2212x1672px: 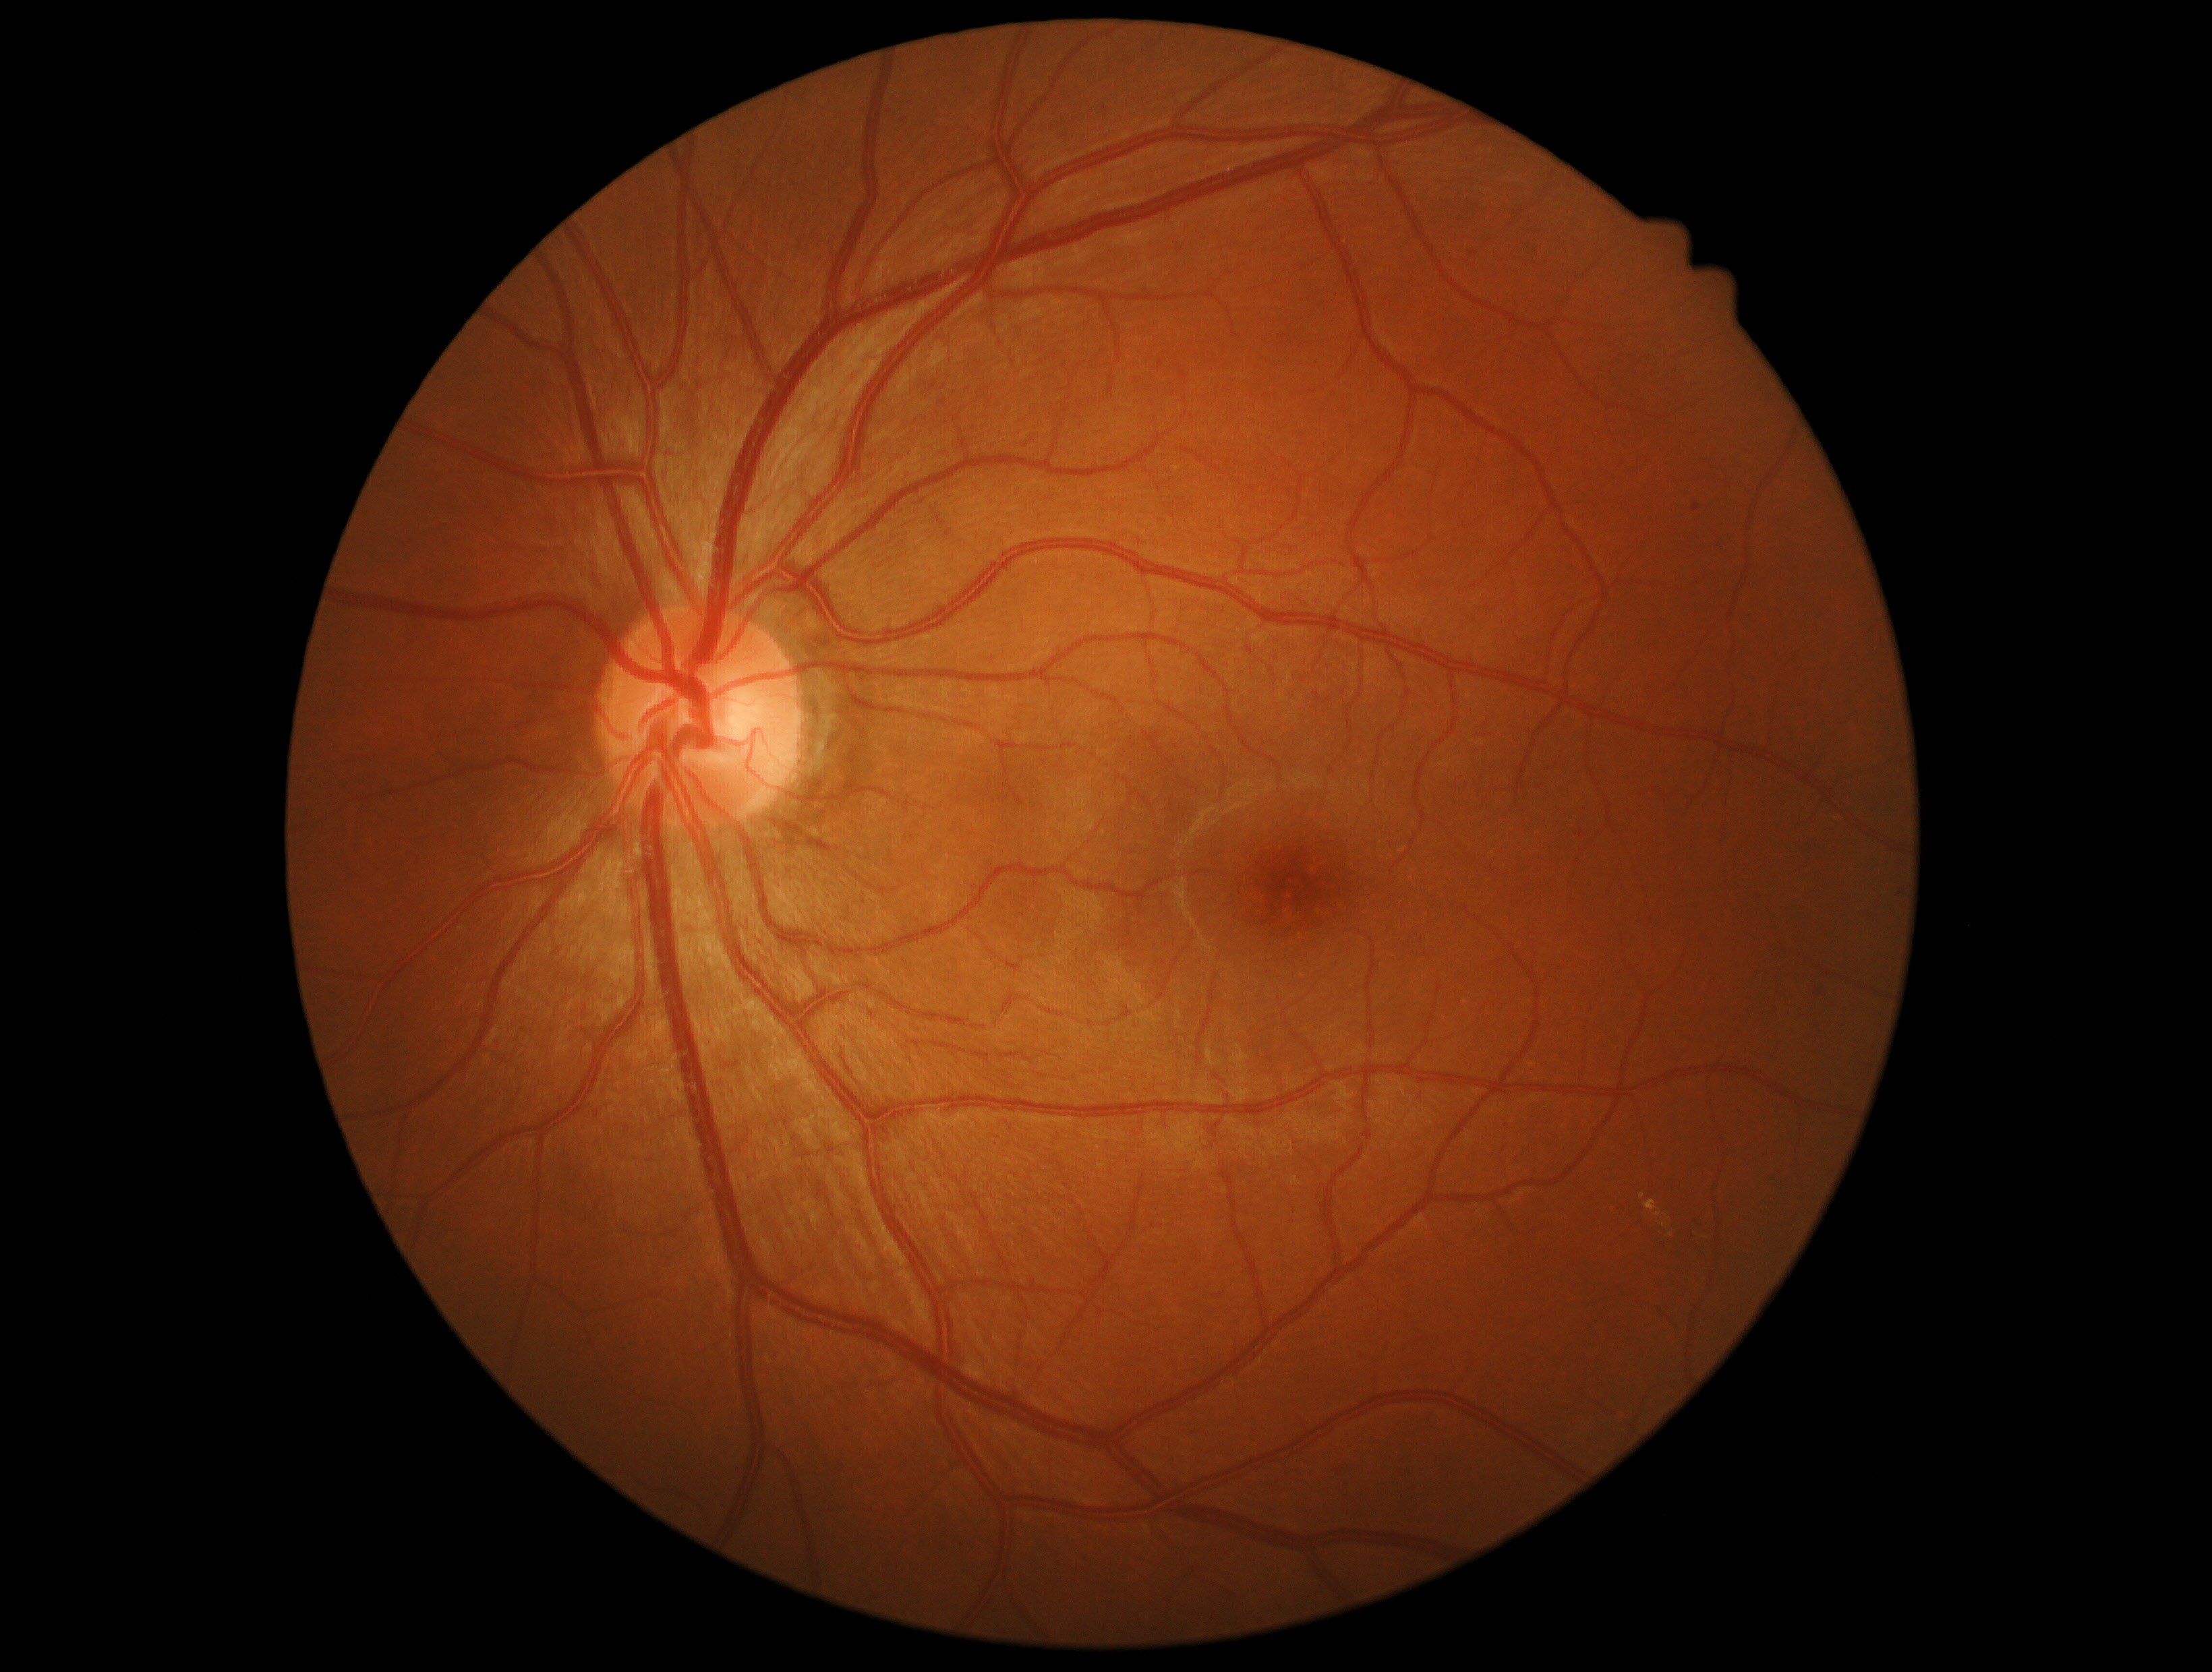
The retinopathy is classified as non-proliferative diabetic retinopathy. Diabetic retinopathy severity is moderate NPDR (grade 2) — more than just microaneurysms but less than severe NPDR.